2346 x 1568 pixels:
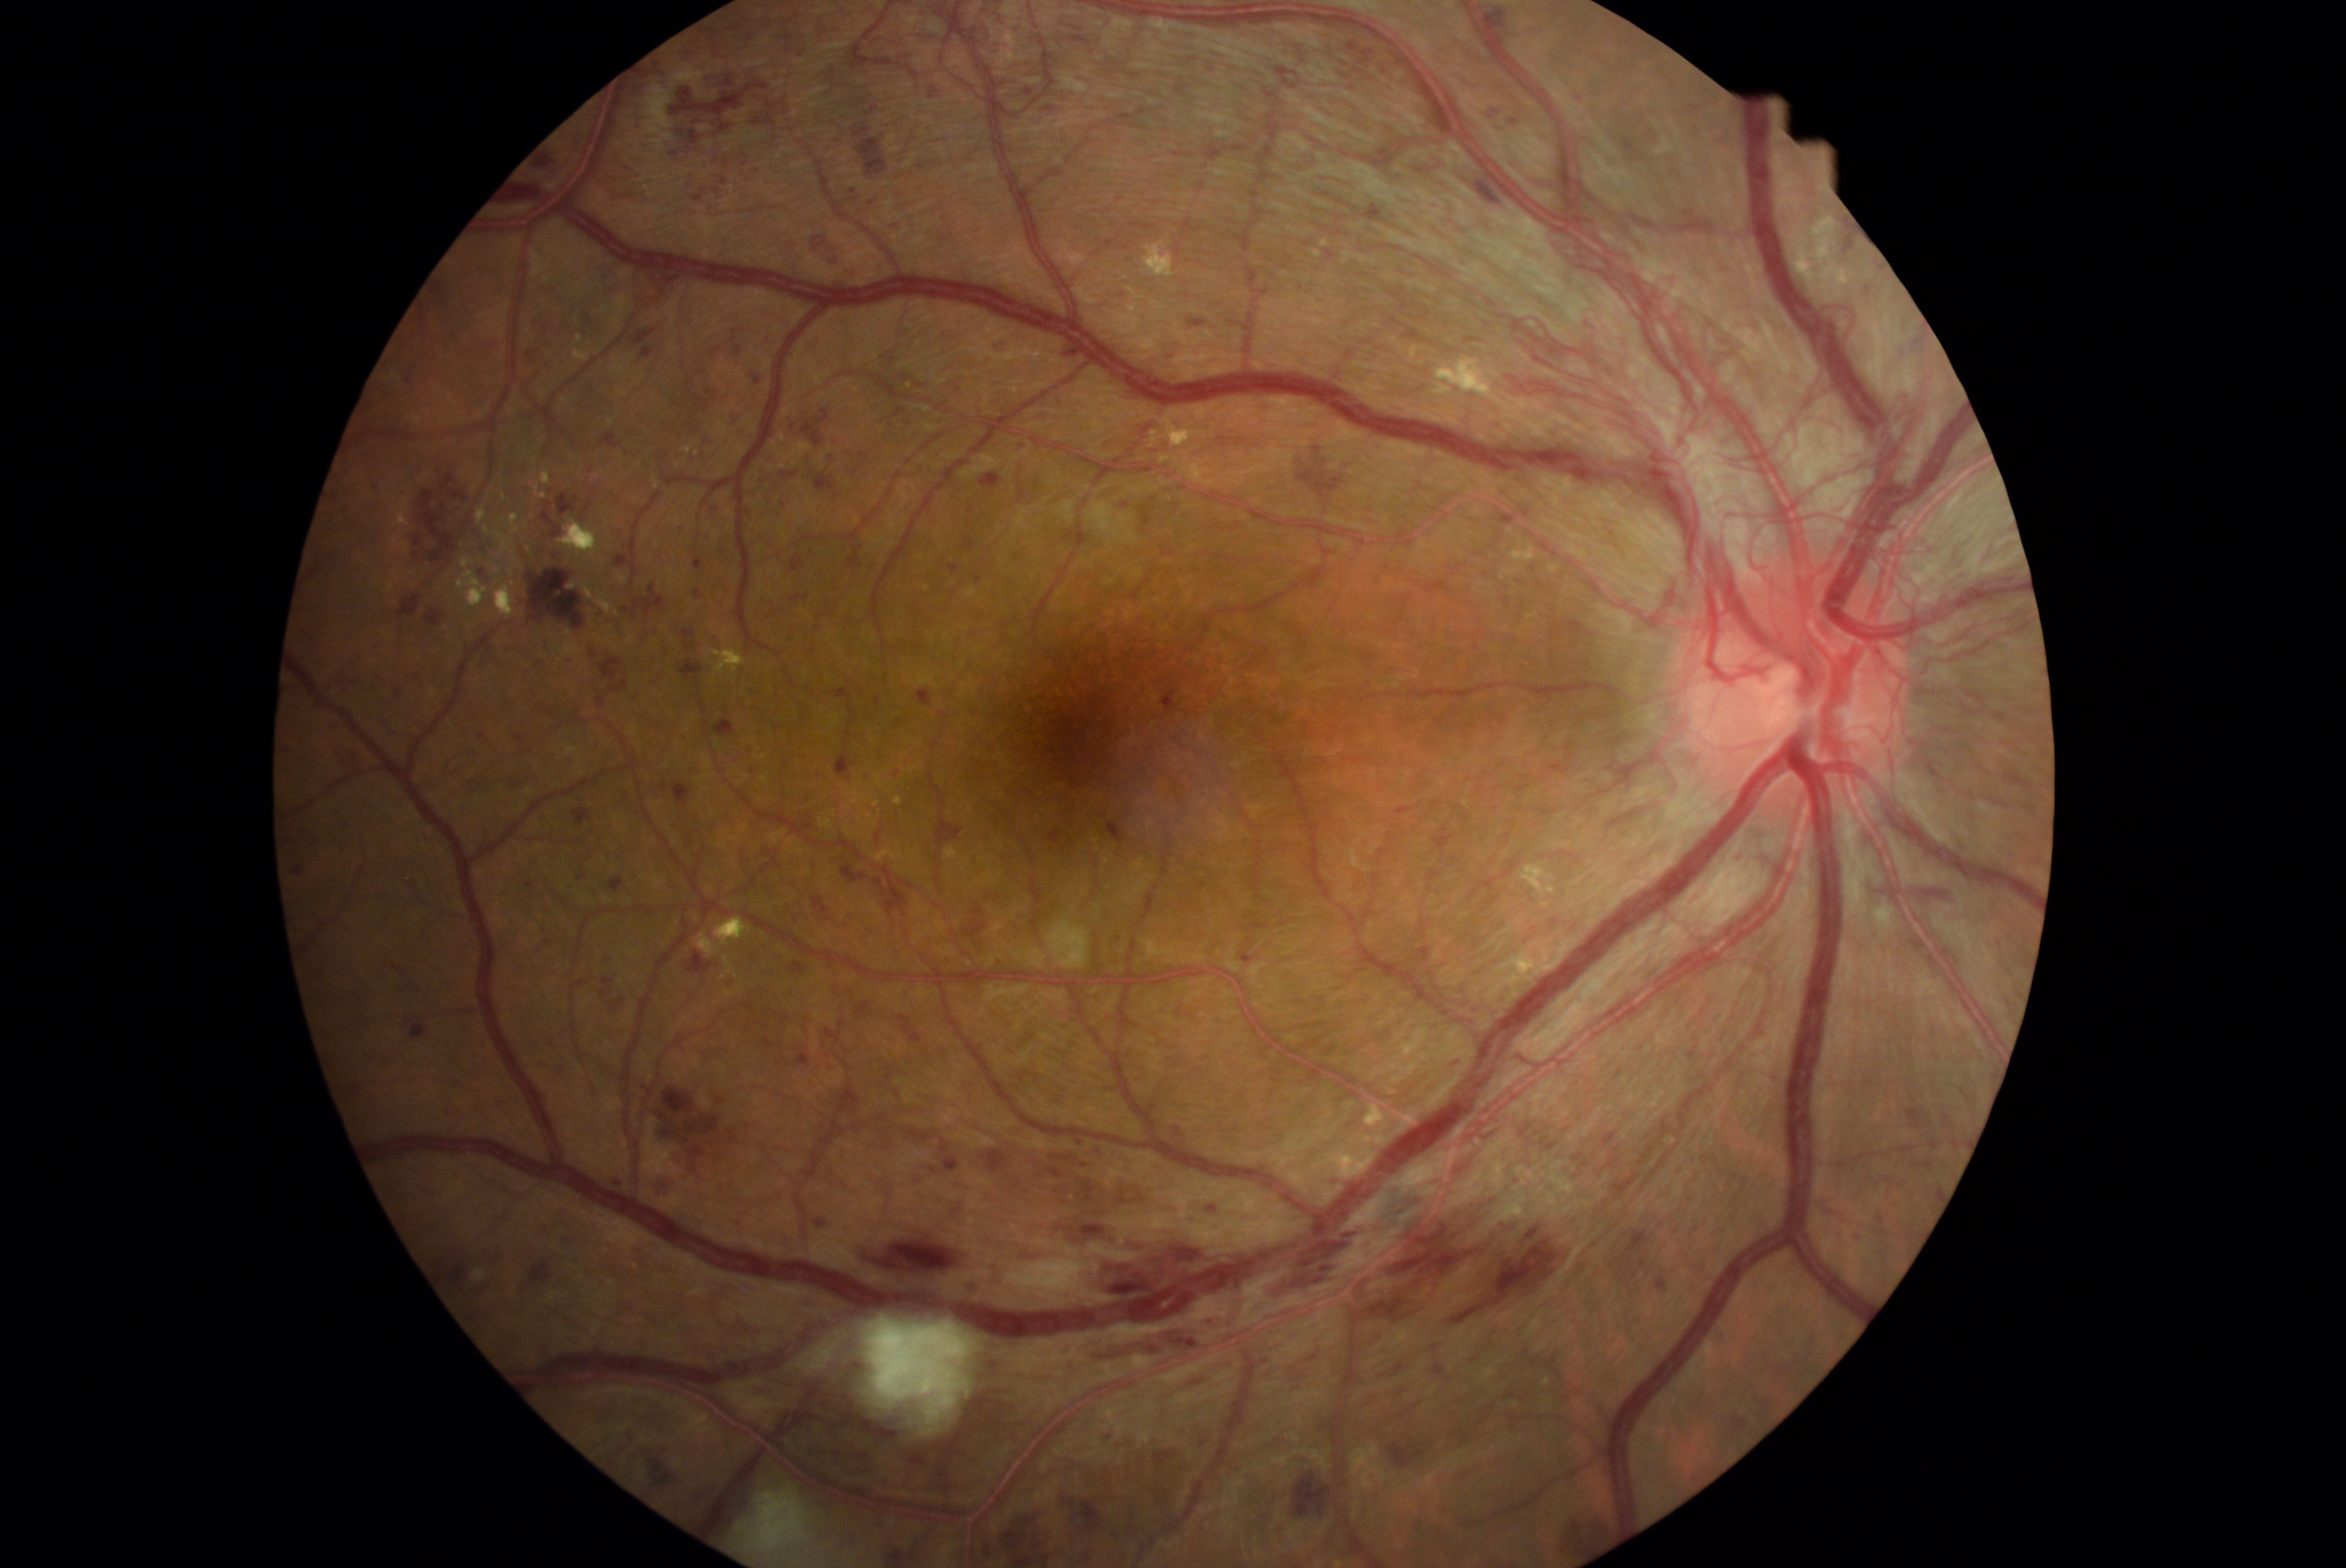 Diabetic retinopathy (DR): proliferative diabetic retinopathy (grade 4) — neovascularization and/or vitreous/pre-retinal hemorrhage
Lesions identified (partial list):
hemorrhages (HEs) (partial): (917,688,932,706) | (1439,1501,1454,1517) | (421,929,434,940) | (1509,1175,1522,1189) | (703,27,730,60) | (1378,1356,1417,1387) | (870,1125,964,1177) | (706,391,719,399) | (1905,1109,1928,1130) | (532,680,587,720) | (747,34,752,42) | (405,1020,430,1044) | (1930,1141,1942,1150) | (537,151,557,170) | (686,379,694,388) | (547,752,557,757) | (346,1083,366,1098) | (1285,1332,1301,1346)
Smaller HEs around (x=690, y=392)